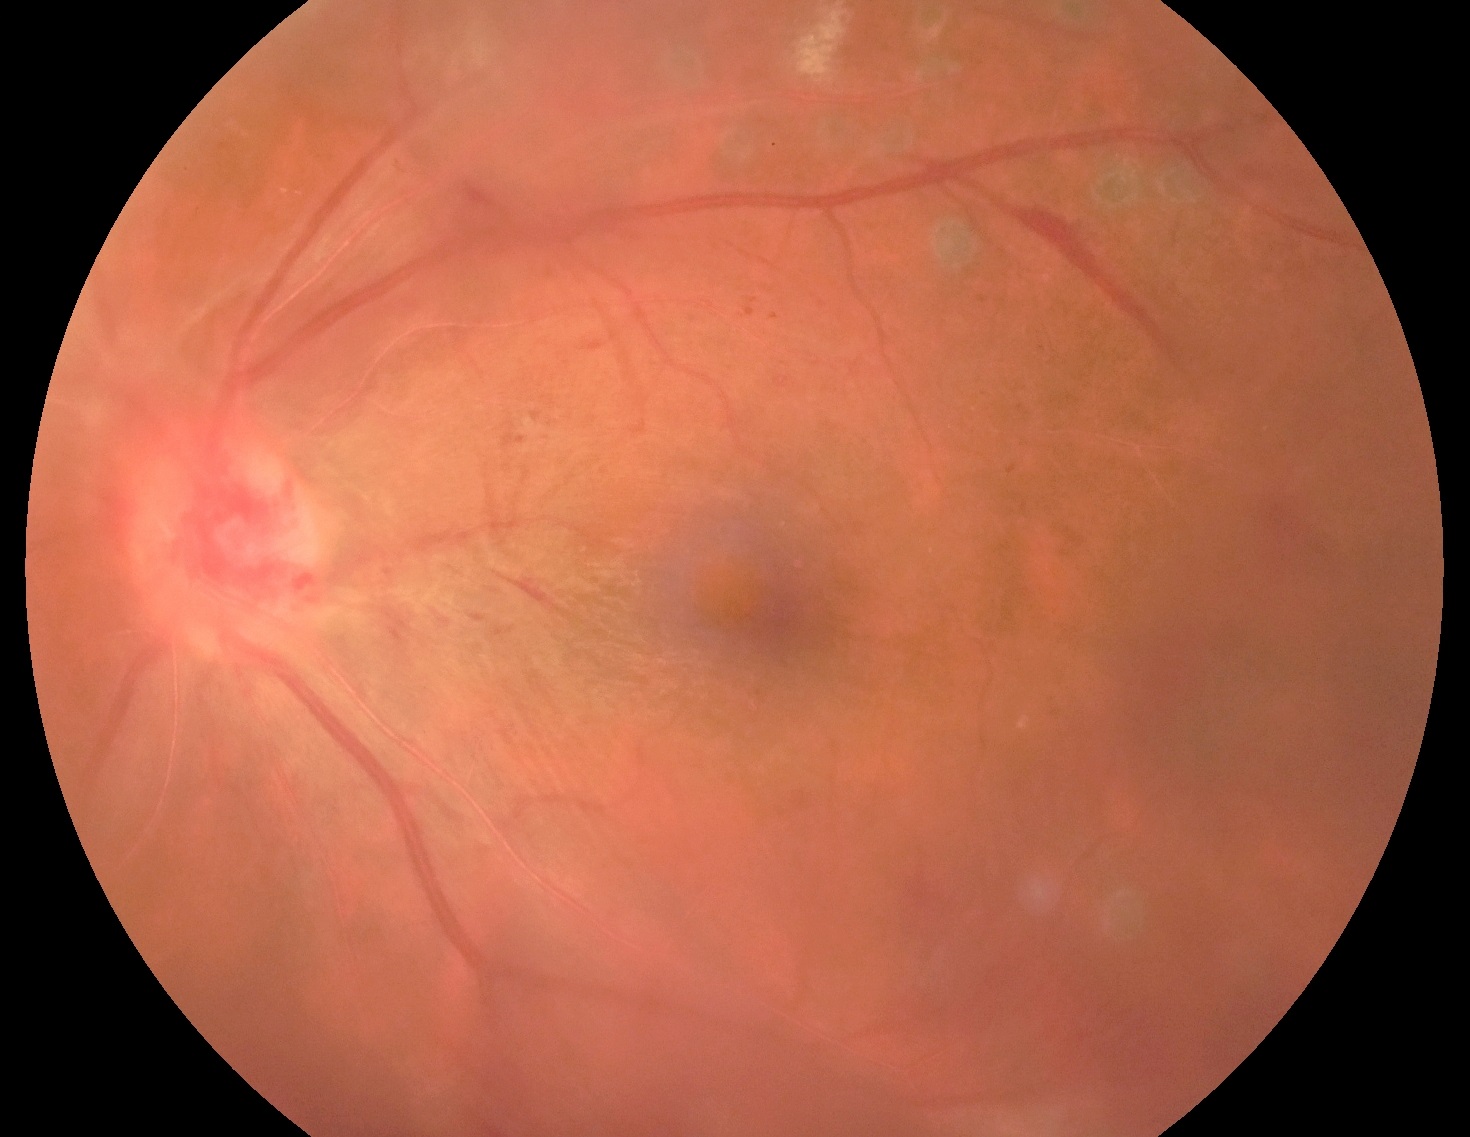 Diabetic retinopathy severity: moderate NPDR (grade 2).